Image size 848x848. 45° FOV: 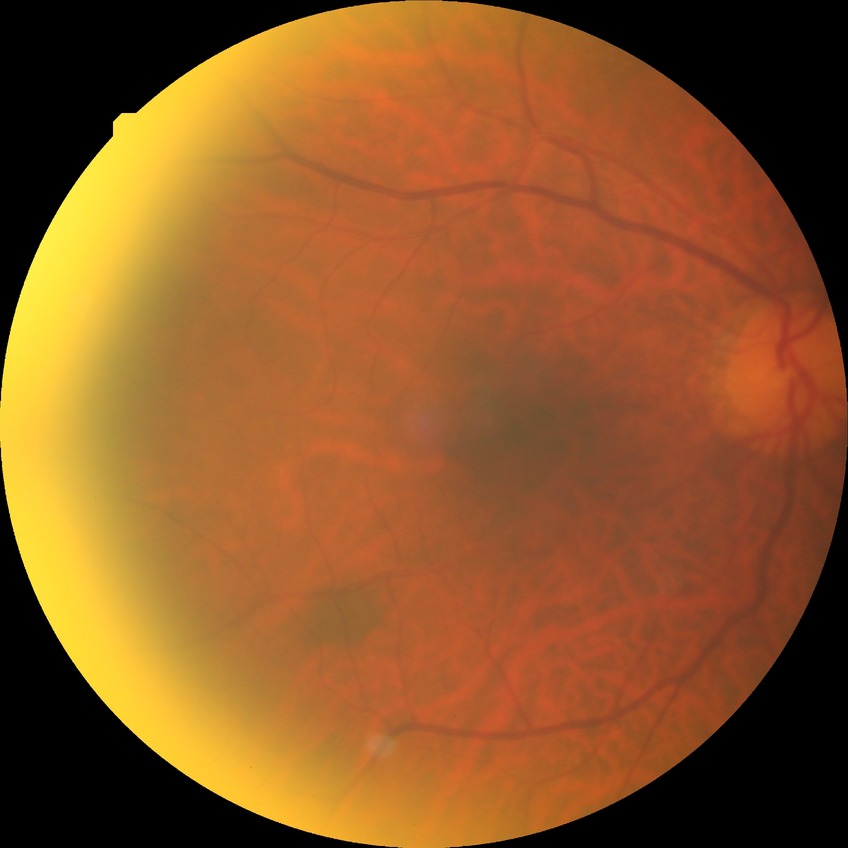

diabetic retinopathy (DR)=no diabetic retinopathy (NDR).